Wide-field contact fundus photograph of an infant — 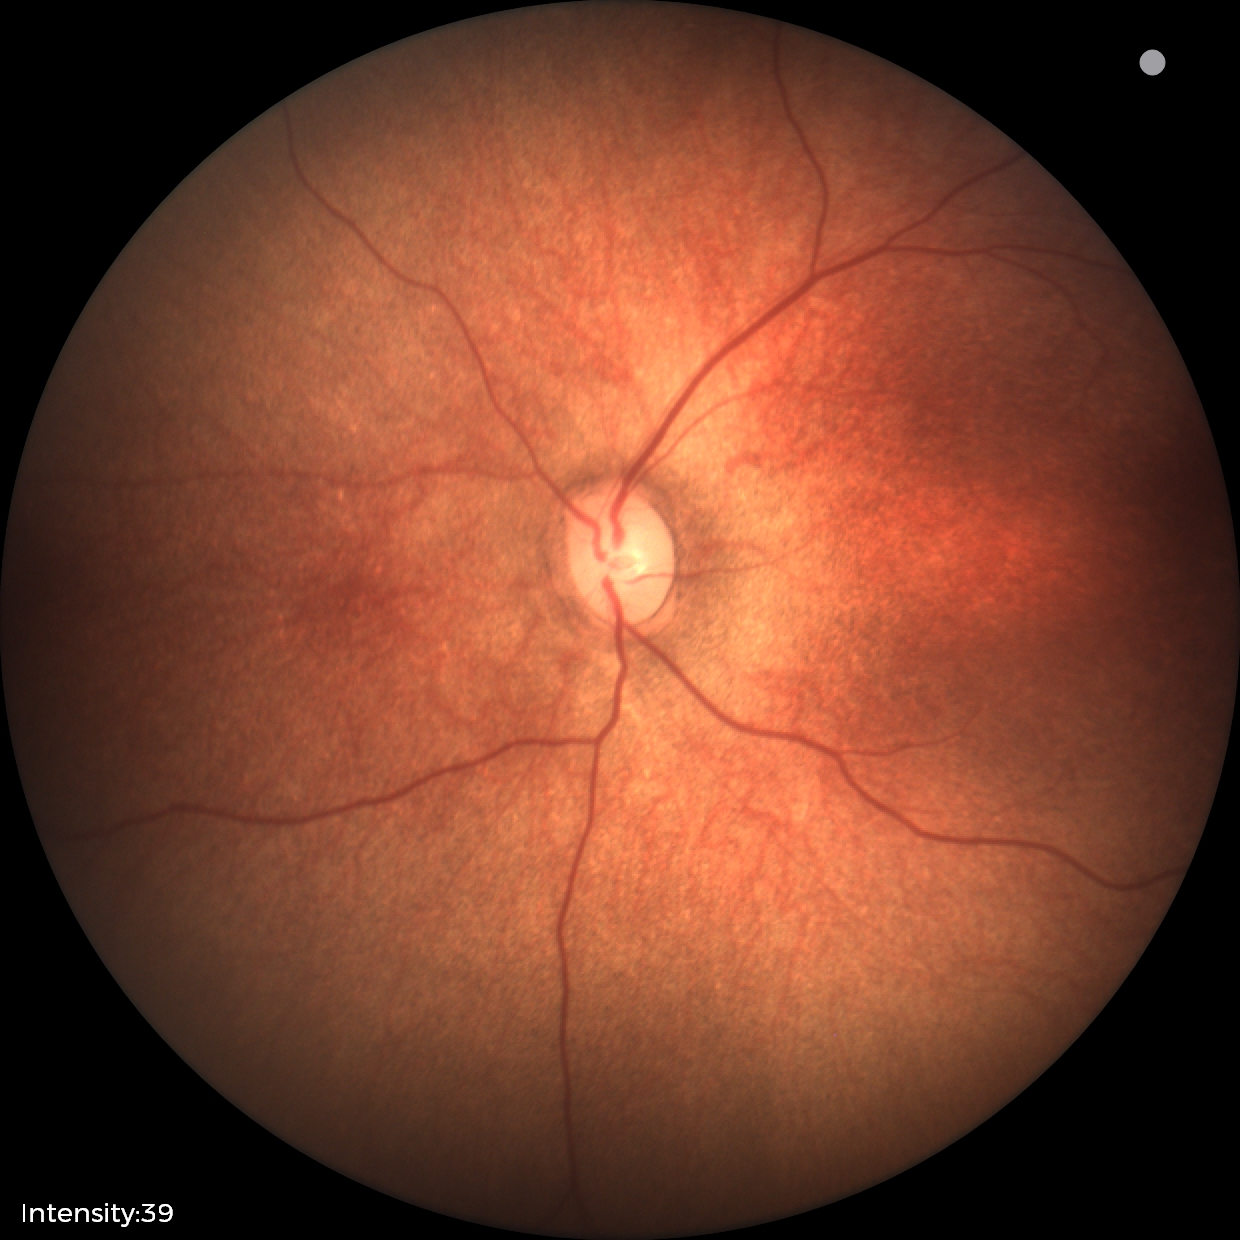 Screening examination with no abnormal retinal findings.